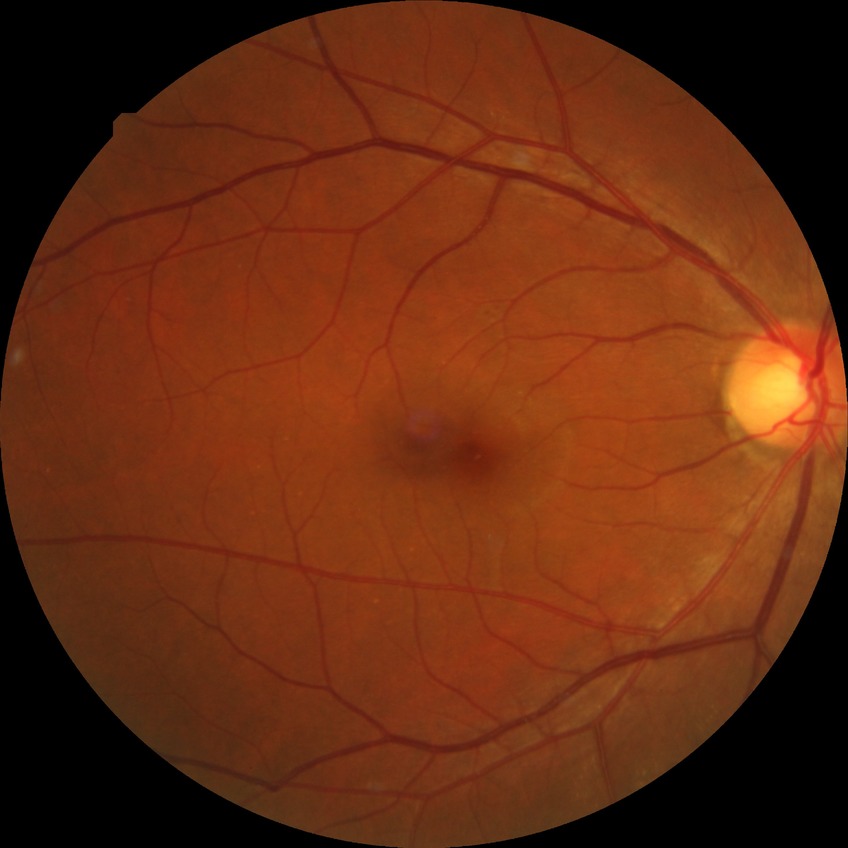   davis_grade: simple diabetic retinopathy